Fundus photo
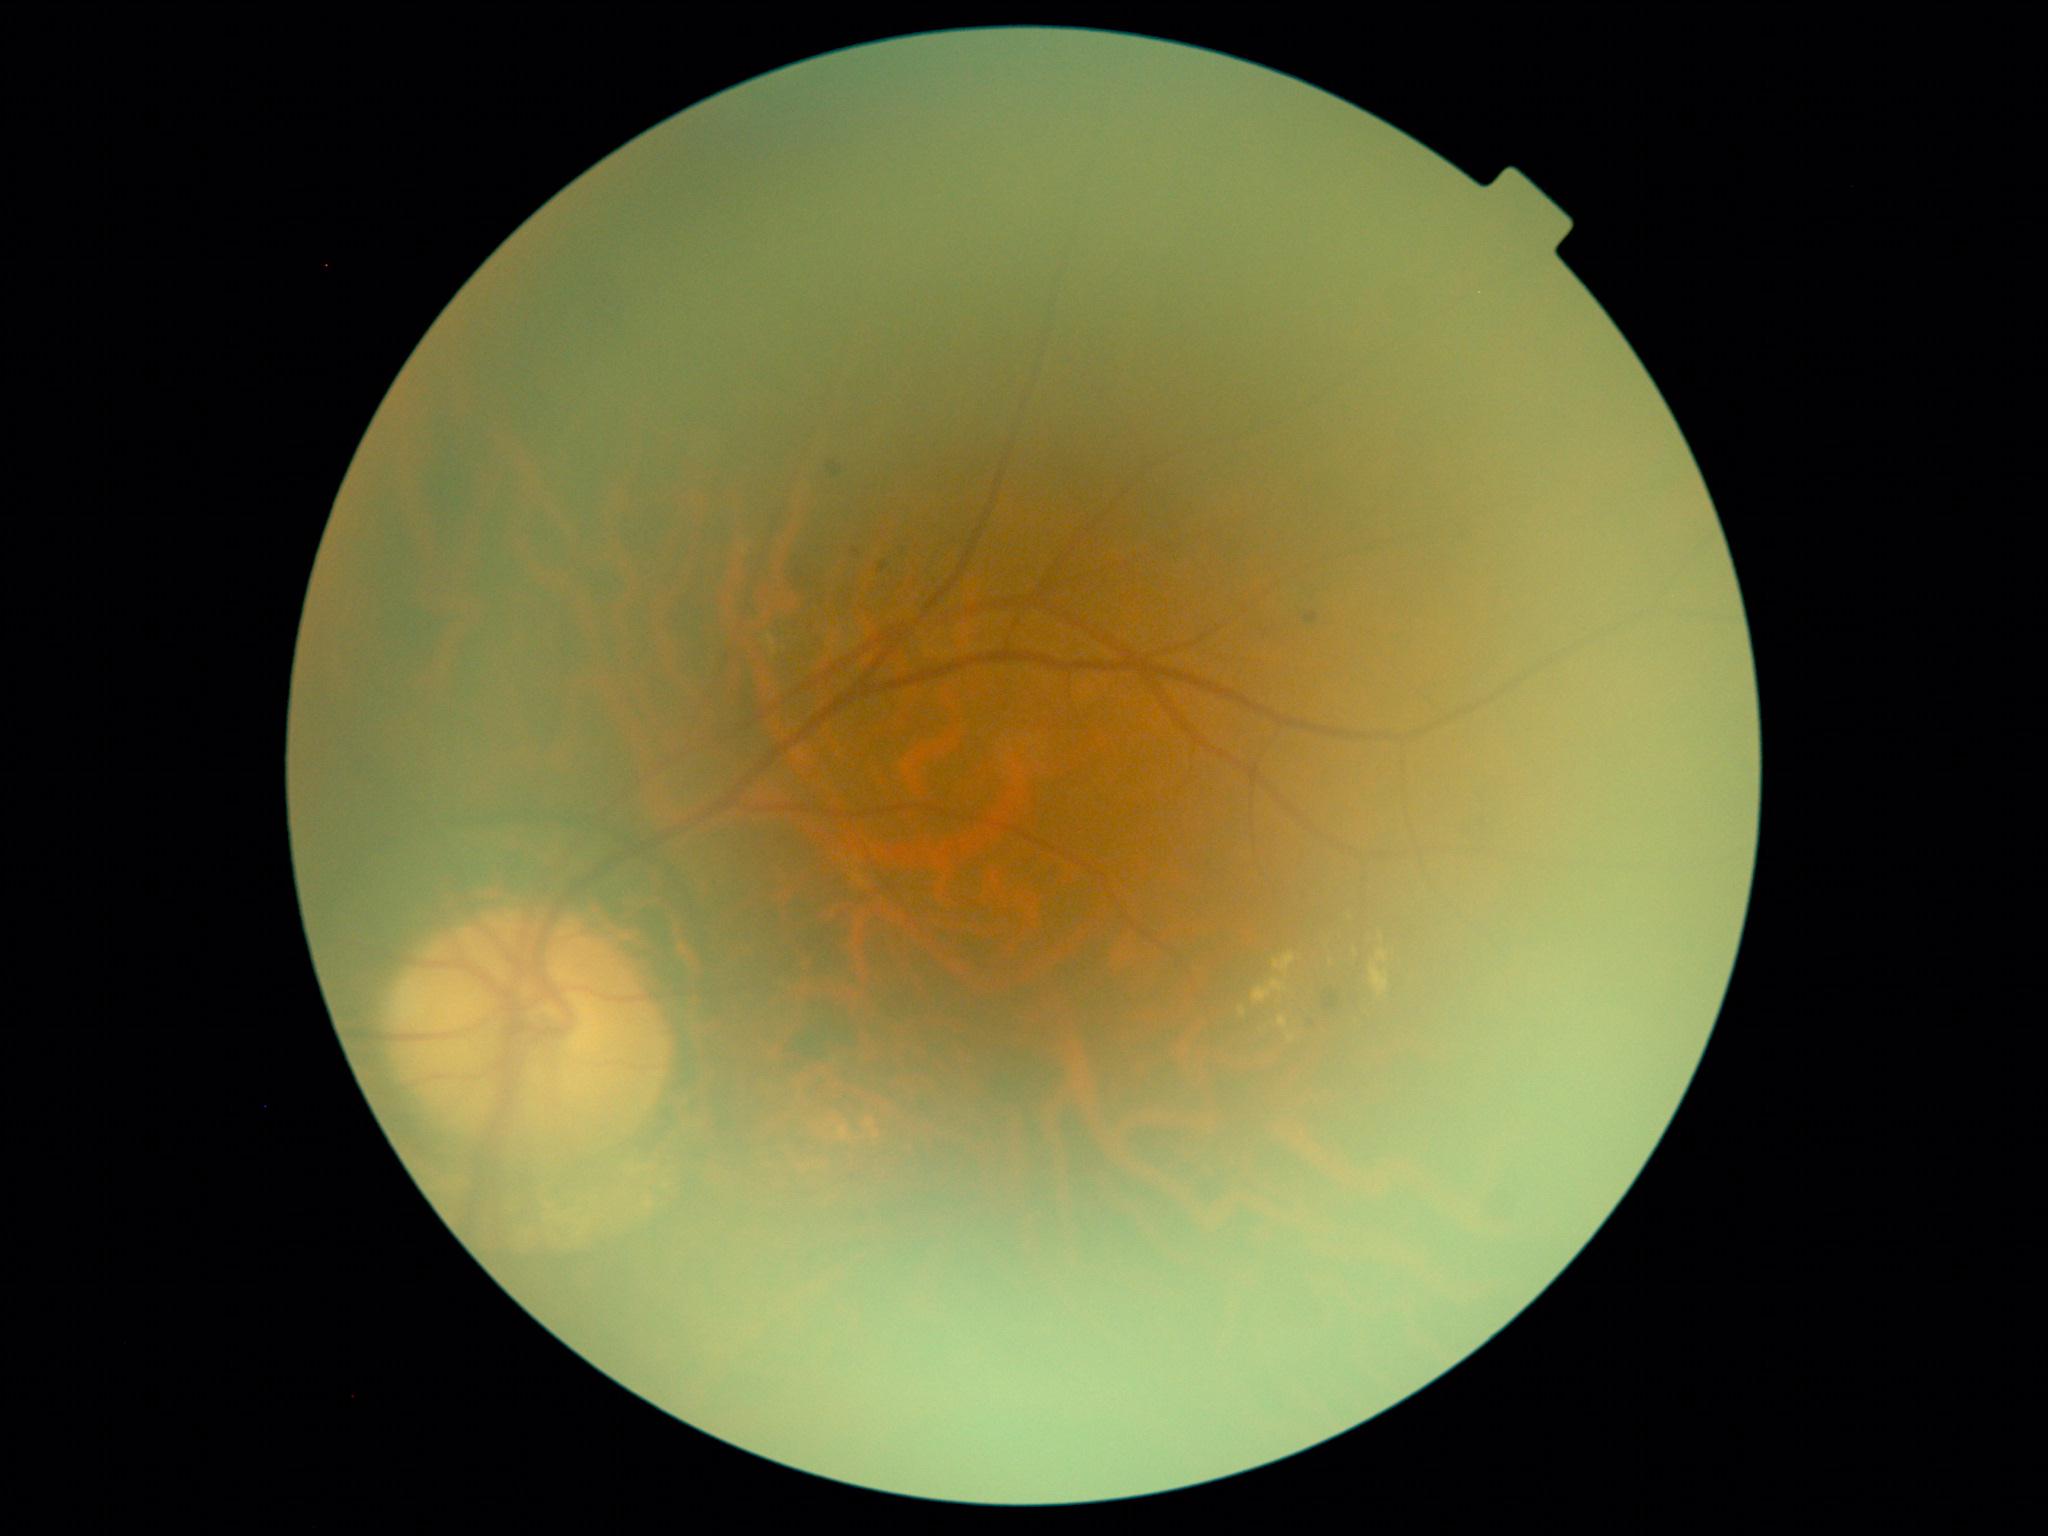 Retinopathy grade is 2 (moderate NPDR). DR class: non-proliferative diabetic retinopathy.